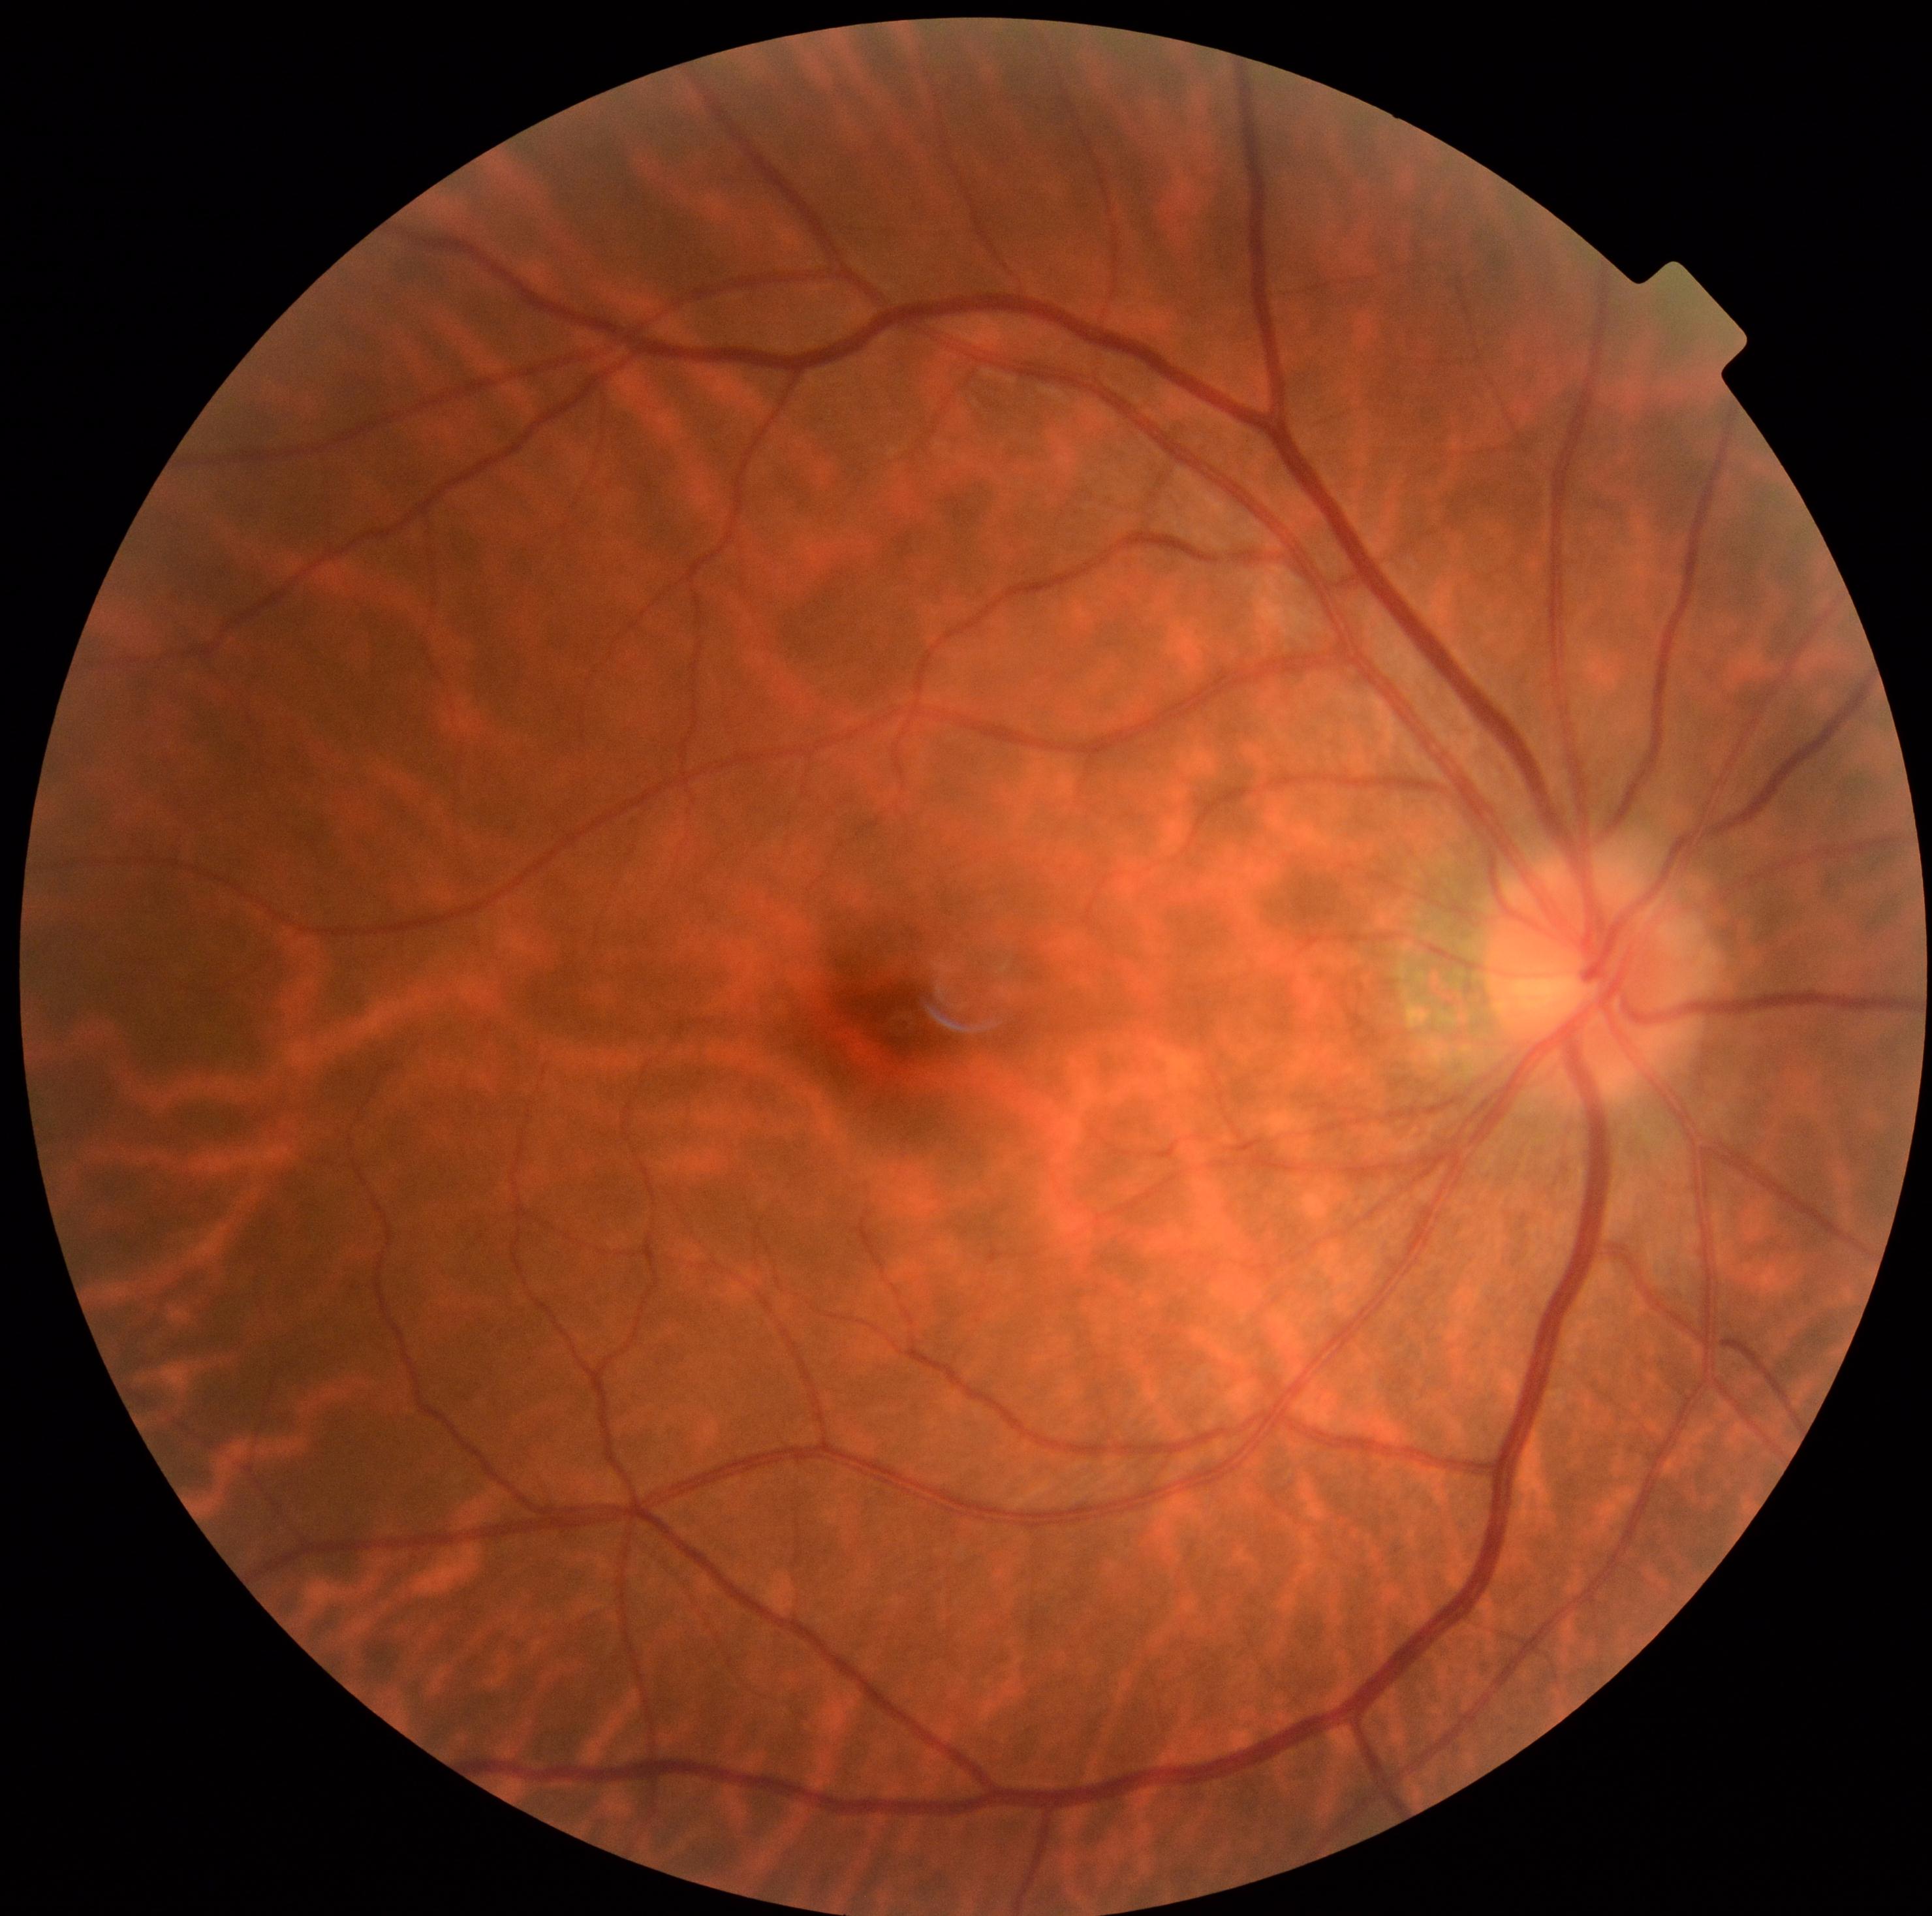 No signs of diabetic retinopathy. DR severity is 0/4 — no visible signs of diabetic retinopathy.